FOV: 45 degrees — 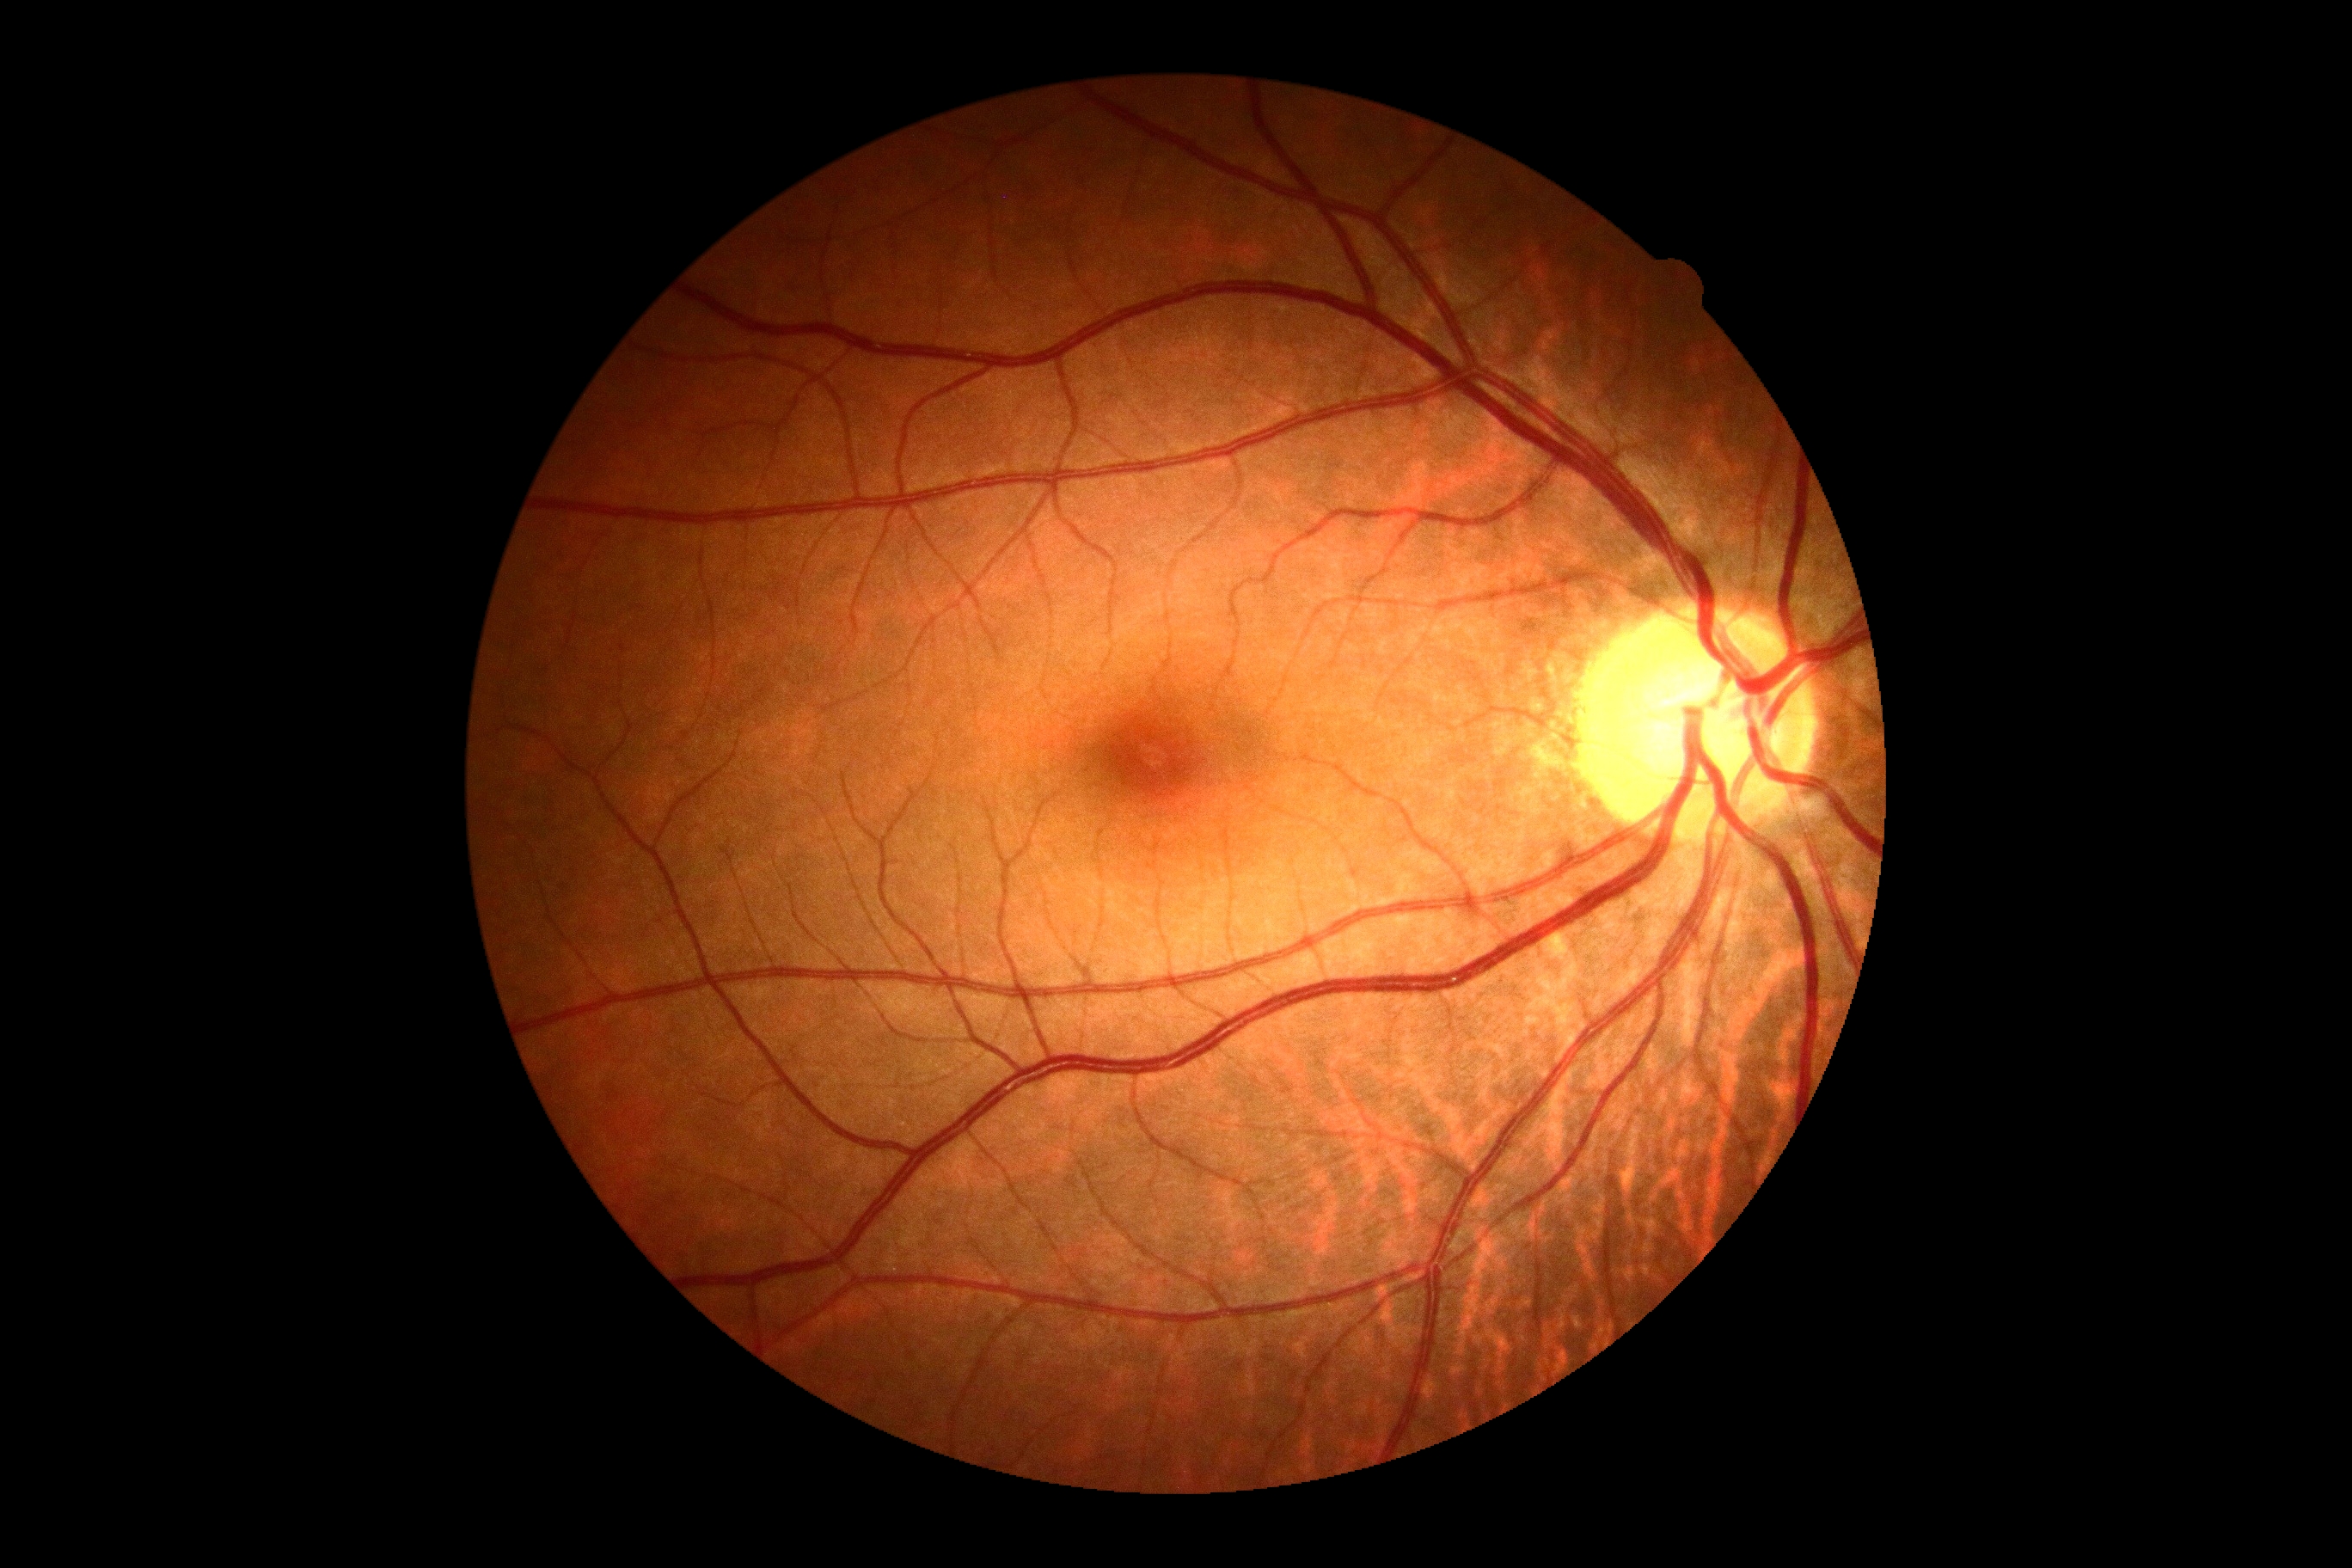
DR severity: 0/4